Color fundus photograph: 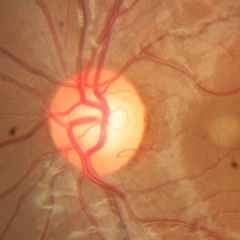 Optic disc appearance consistent with no evidence of glaucoma.